Pediatric wide-field fundus photograph:
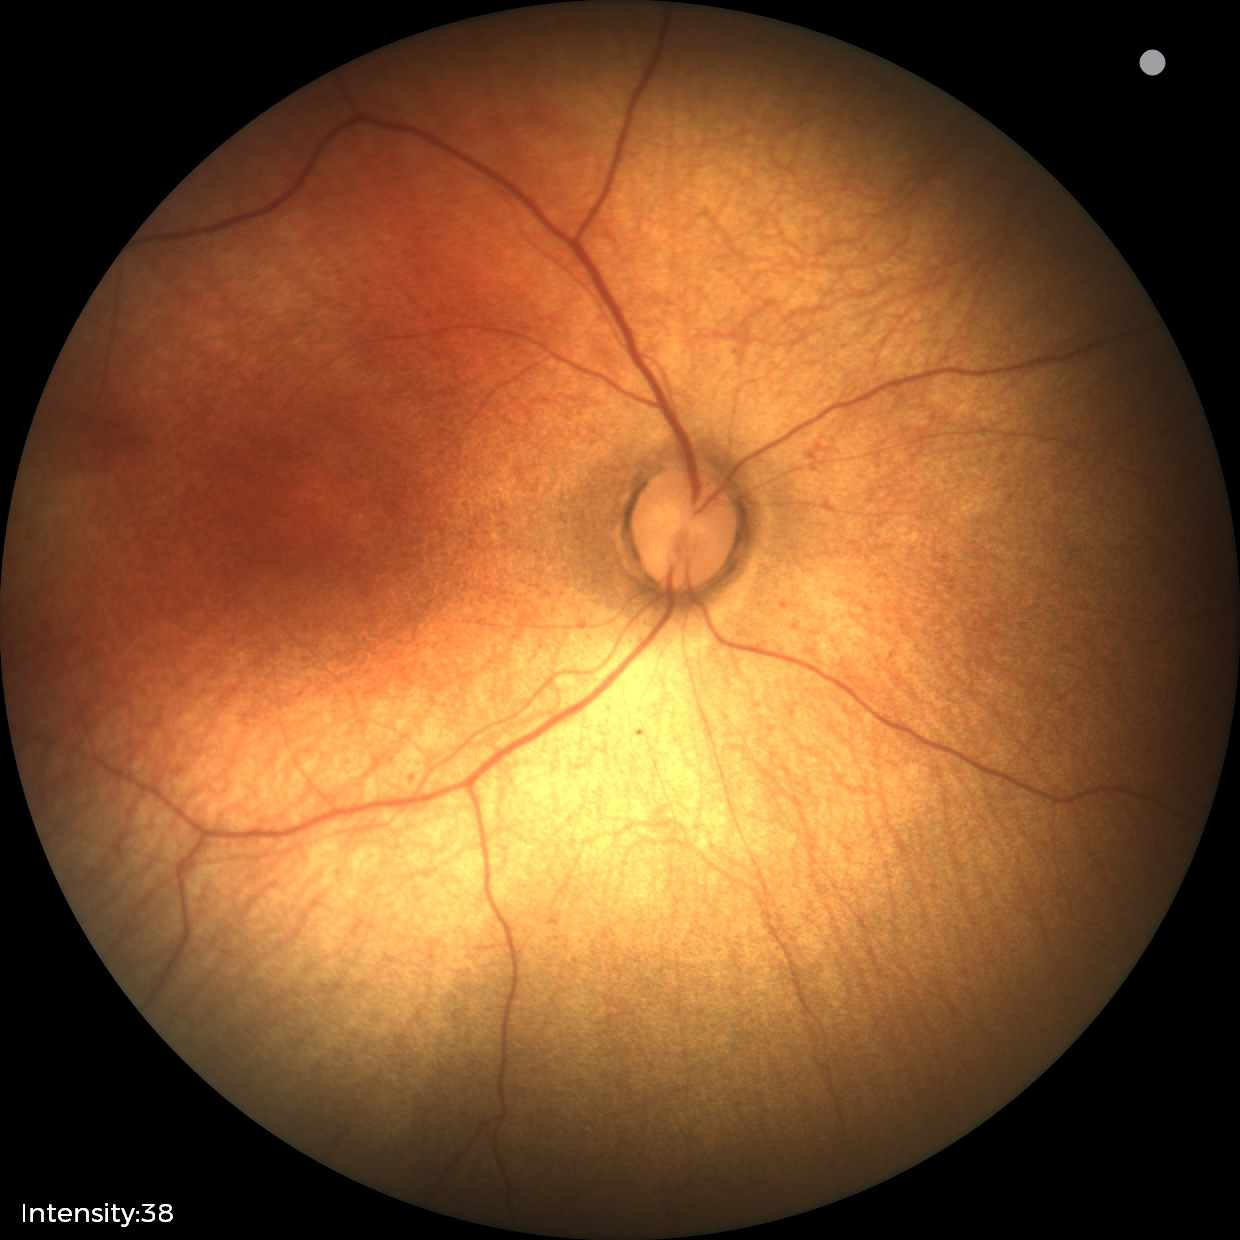 Screening examination diagnosed as physiological.